Infant wide-field fundus photograph
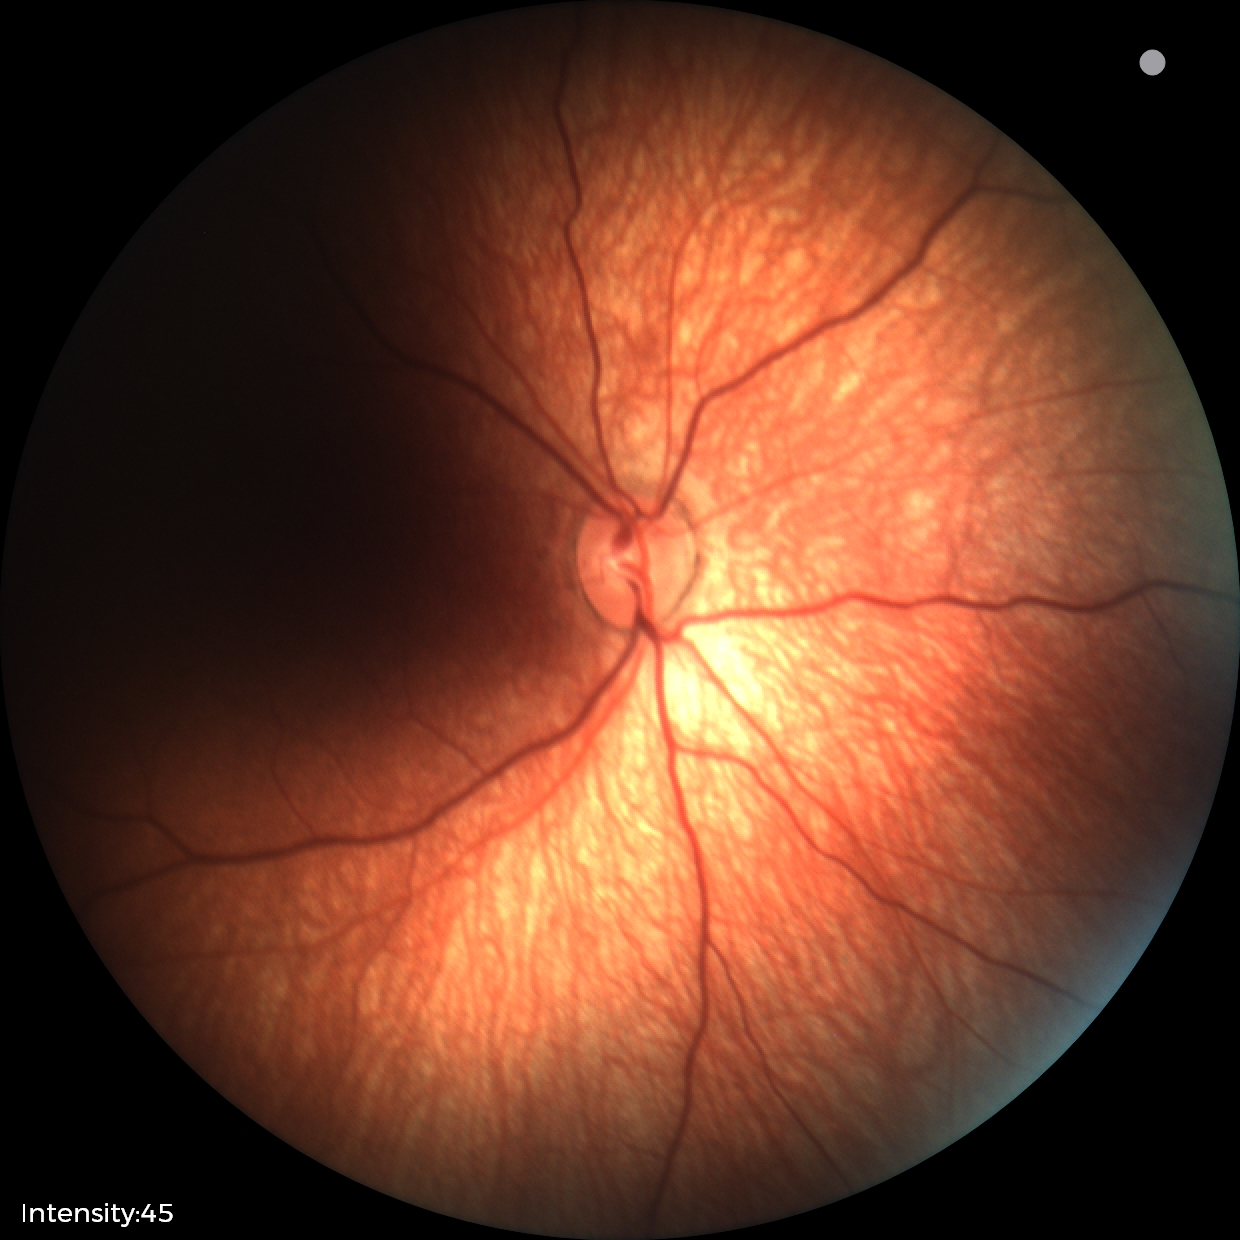
Finding: normal retinal appearance.